Pediatric wide-field fundus photograph · acquired on the Natus RetCam Envision:
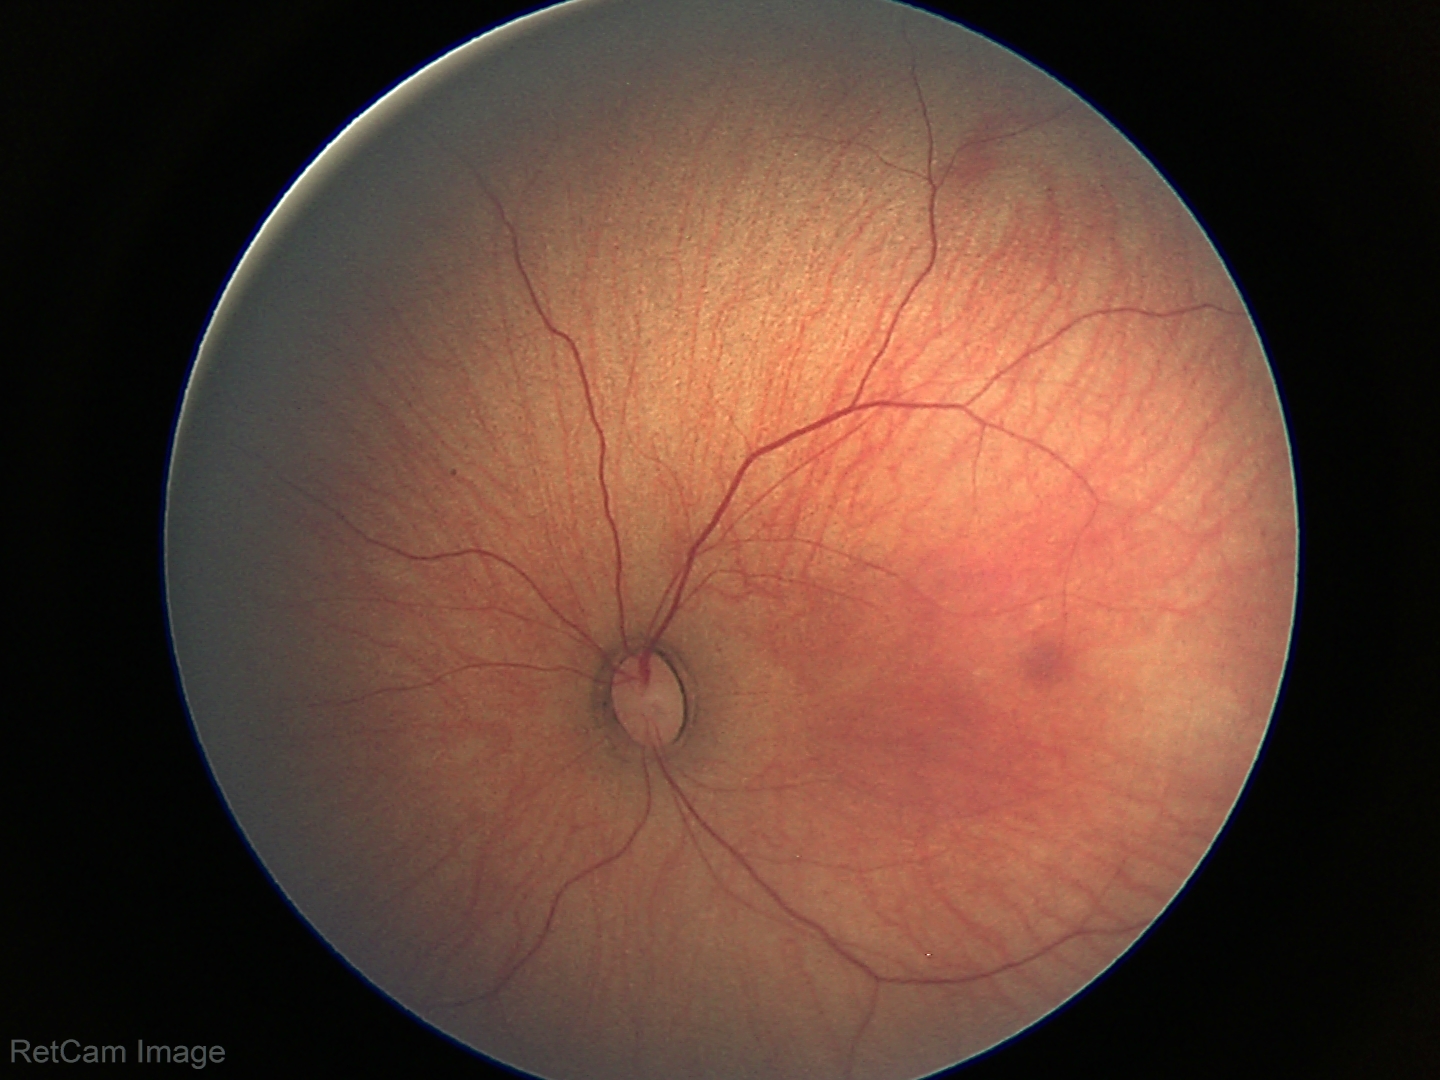 Screening examination with no abnormal retinal findings.